1380 by 1382 pixels. 45° FOV — 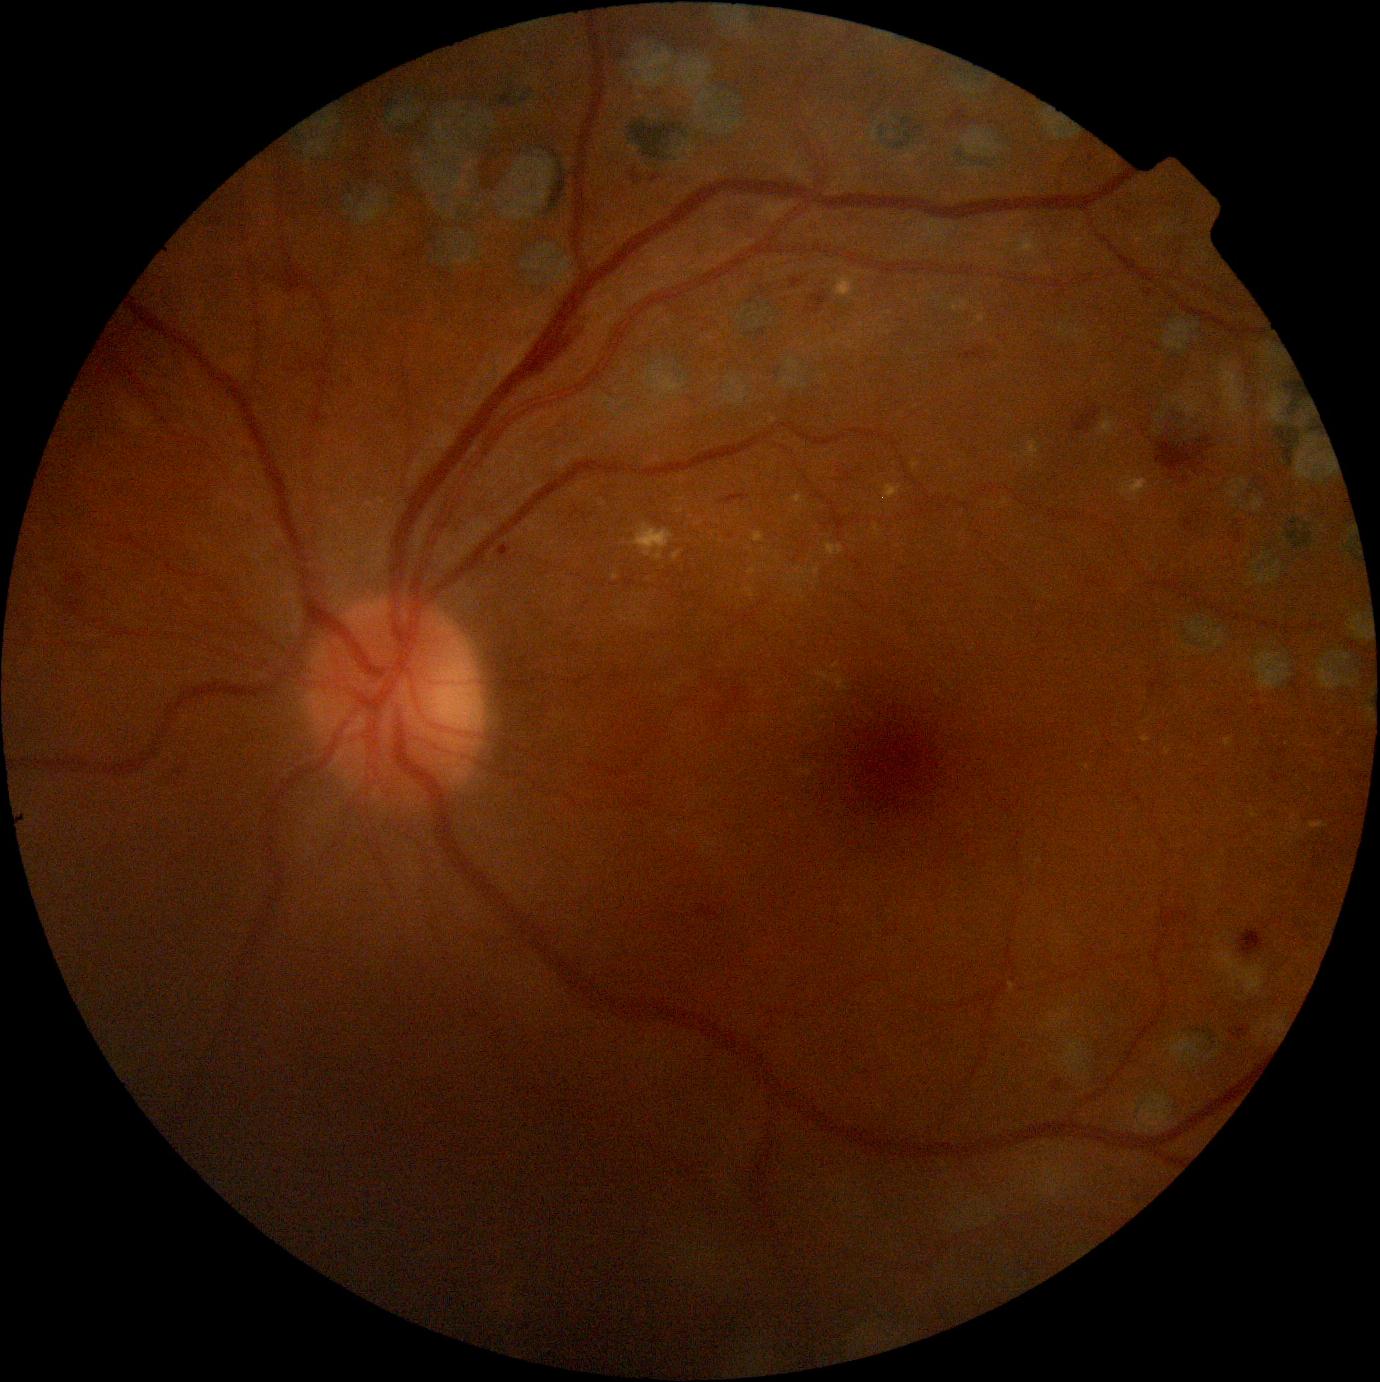

<lesions partial="true">
  <dr_grade>2</dr_grade>
  <ex partial="true">{"left": 1224, "top": 738, "right": 1235, "bottom": 748}, {"left": 1142, "top": 736, "right": 1151, "bottom": 744}, {"left": 825, "top": 543, "right": 844, "bottom": 557}, {"left": 793, "top": 567, "right": 820, "bottom": 582}, {"left": 1023, "top": 441, "right": 1042, "bottom": 464}, {"left": 1120, "top": 477, "right": 1150, "bottom": 504}, {"left": 630, "top": 523, "right": 674, "bottom": 561}, {"left": 792, "top": 495, "right": 806, "bottom": 504}, {"left": 748, "top": 566, "right": 757, "bottom": 576}, {"left": 752, "top": 532, "right": 765, "bottom": 543}</ex>
  <ex_small_centers>(807, 582)</ex_small_centers>
  <ma>{"left": 1185, "top": 518, "right": 1198, "bottom": 533}, {"left": 1236, "top": 530, "right": 1243, "bottom": 545}, {"left": 498, "top": 546, "right": 511, "bottom": 557}, {"left": 804, "top": 292, "right": 829, "bottom": 314}, {"left": 651, "top": 176, "right": 662, "bottom": 184}, {"left": 790, "top": 279, "right": 802, "bottom": 289}, {"left": 631, "top": 170, "right": 642, "bottom": 185}, {"left": 1051, "top": 1079, "right": 1064, "bottom": 1093}</ma>
  <se />
  <he>{"left": 960, "top": 347, "right": 988, "bottom": 360}, {"left": 1073, "top": 406, "right": 1103, "bottom": 434}, {"left": 285, "top": 266, "right": 311, "bottom": 294}, {"left": 952, "top": 110, "right": 967, "bottom": 126}, {"left": 720, "top": 491, "right": 750, "bottom": 505}, {"left": 176, "top": 768, "right": 184, "bottom": 777}, {"left": 530, "top": 323, "right": 583, "bottom": 376}, {"left": 67, "top": 573, "right": 84, "bottom": 588}, {"left": 1231, "top": 1025, "right": 1251, "bottom": 1041}, {"left": 1156, "top": 437, "right": 1216, "bottom": 475}, {"left": 1240, "top": 931, "right": 1266, "bottom": 957}</he>
</lesions>